Captured on a Forus 3Nethra Classic, CFP — 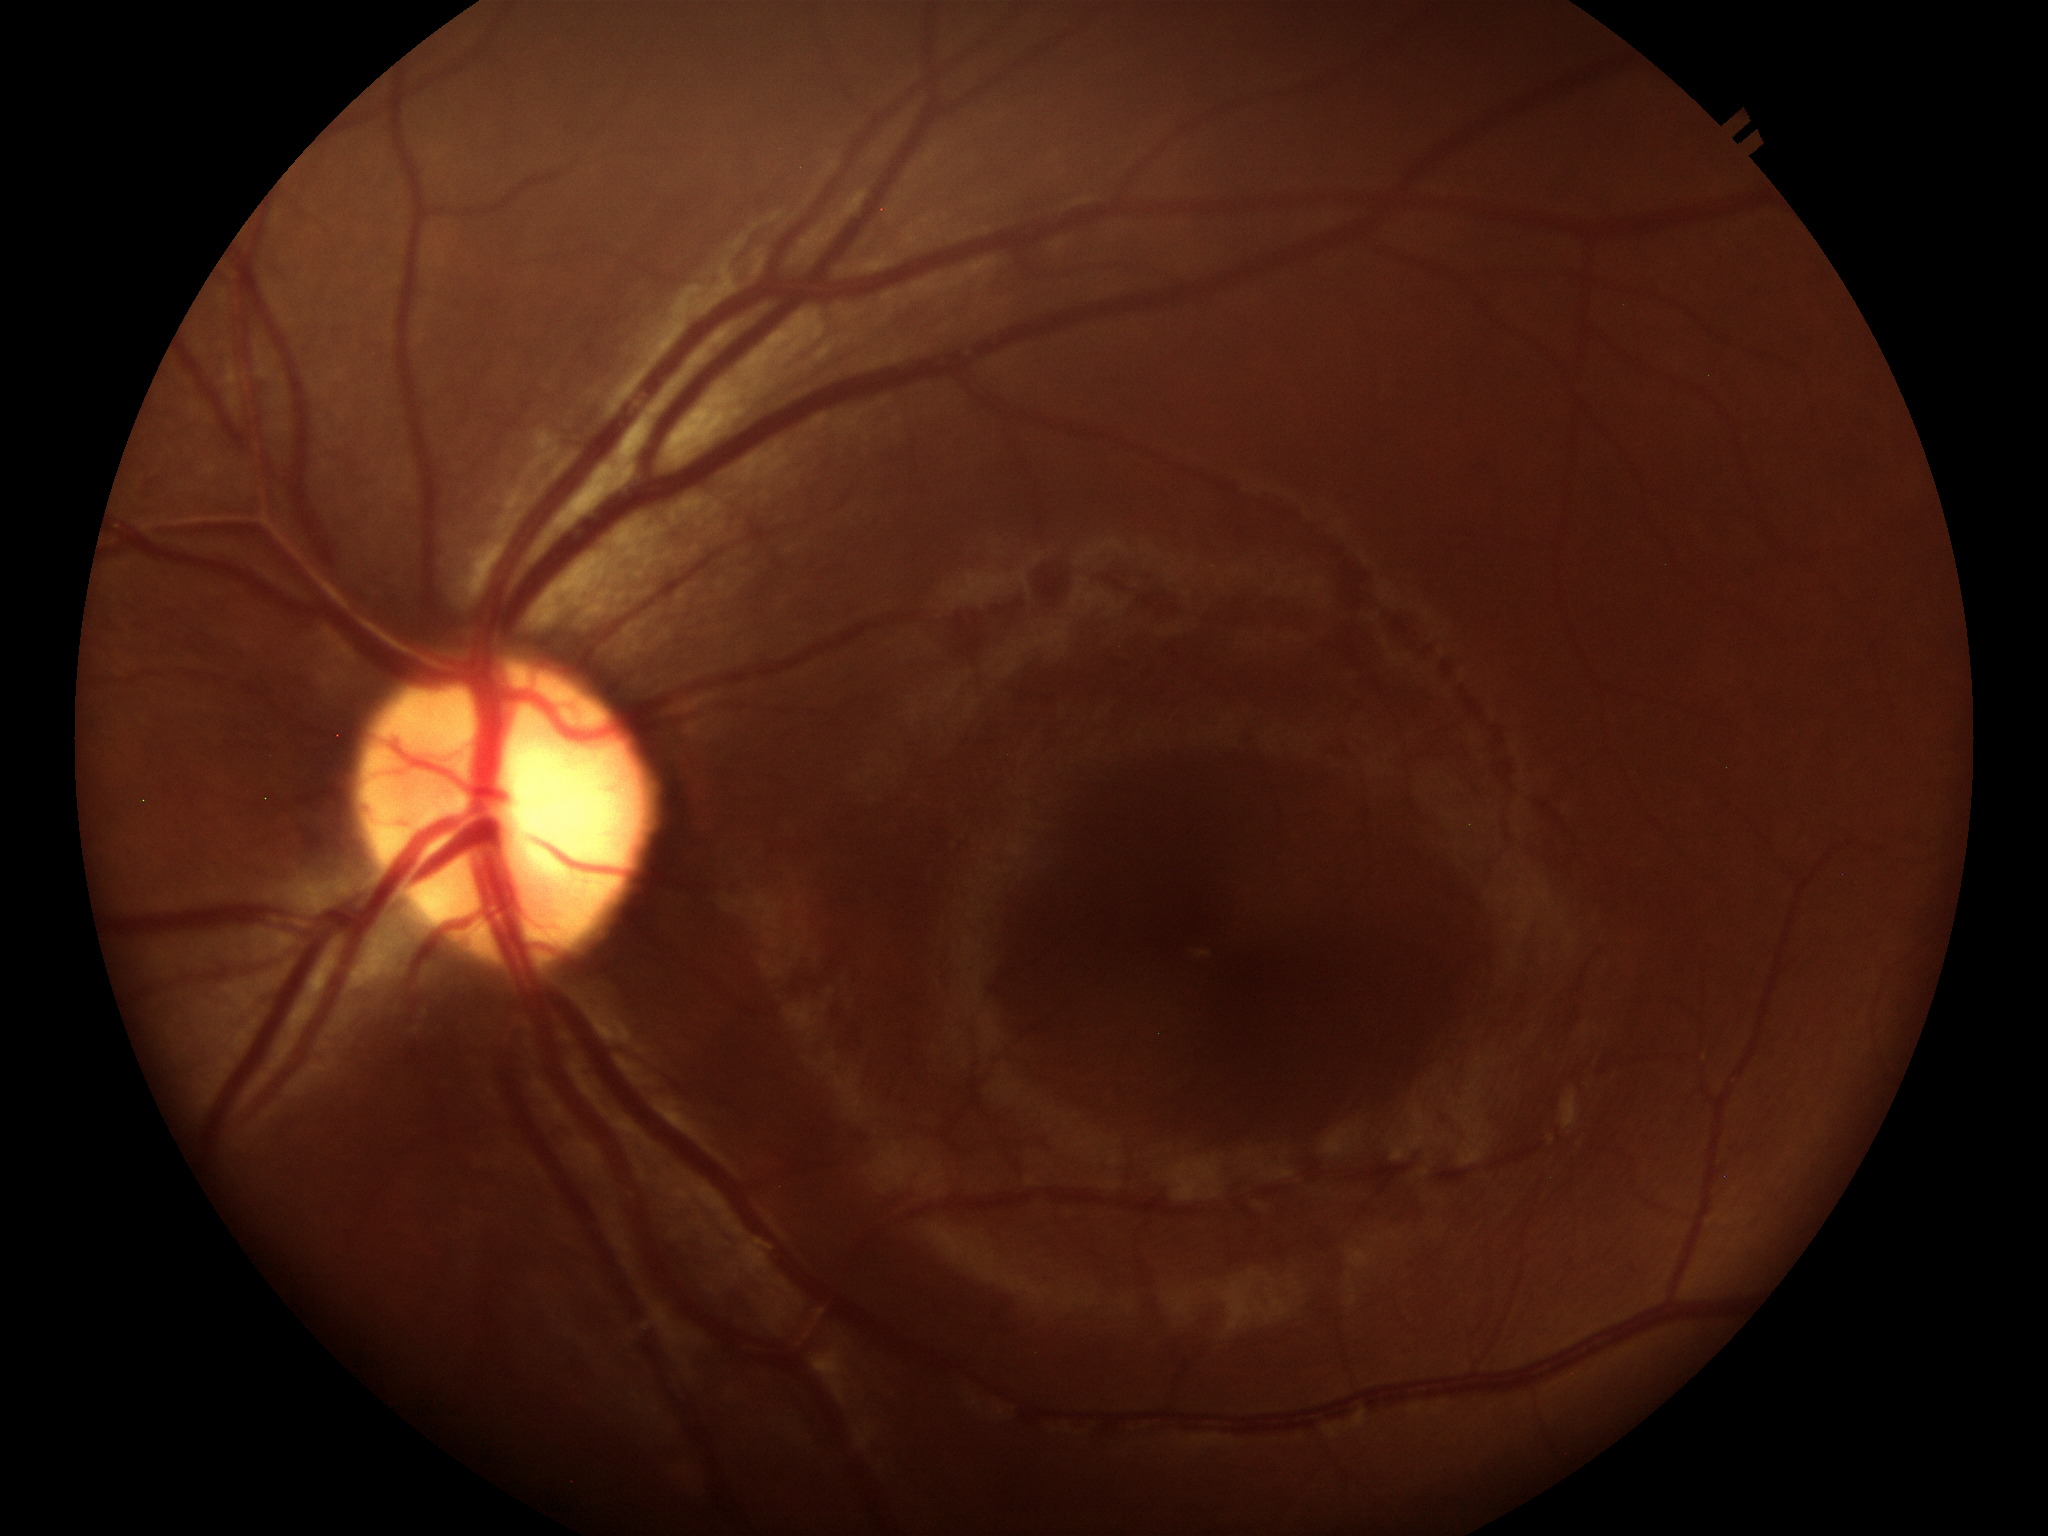 Glaucoma evaluation: negative. Vertical cup-to-disc ratio: 0.56. Area cup-disc ratio: 0.26.